Davis DR grading. 848 by 848 pixels. NIDEK AFC-230 fundus camera. 45-degree field of view. Color fundus image: 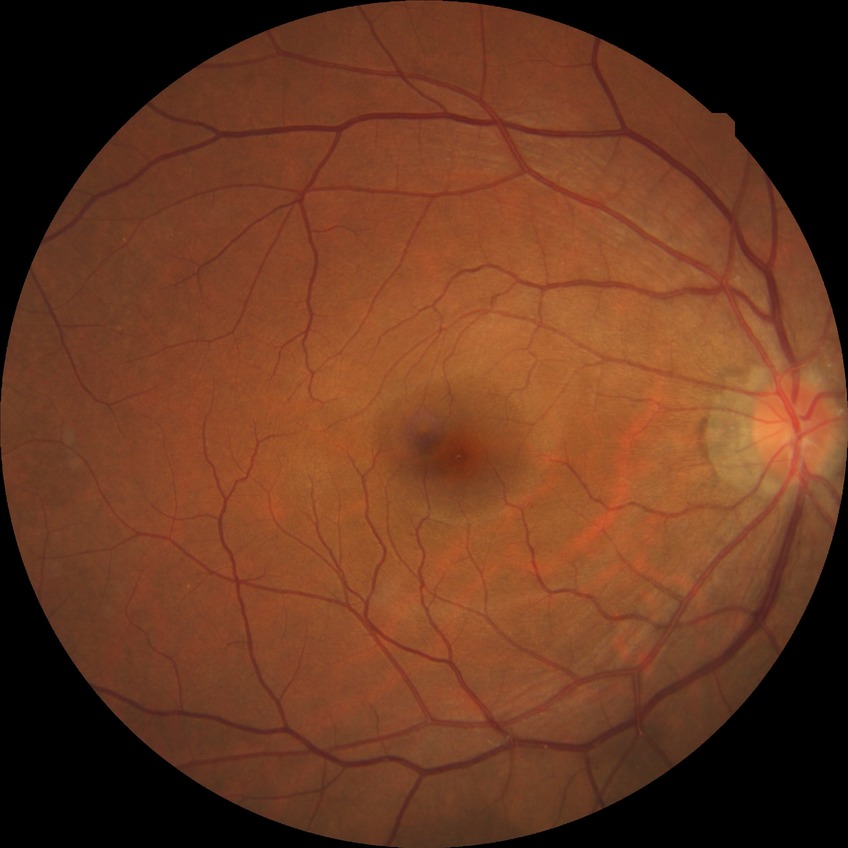 Modified Davis grading: simple diabetic retinopathy.